1240 by 1240 pixels · infant wide-field retinal image: 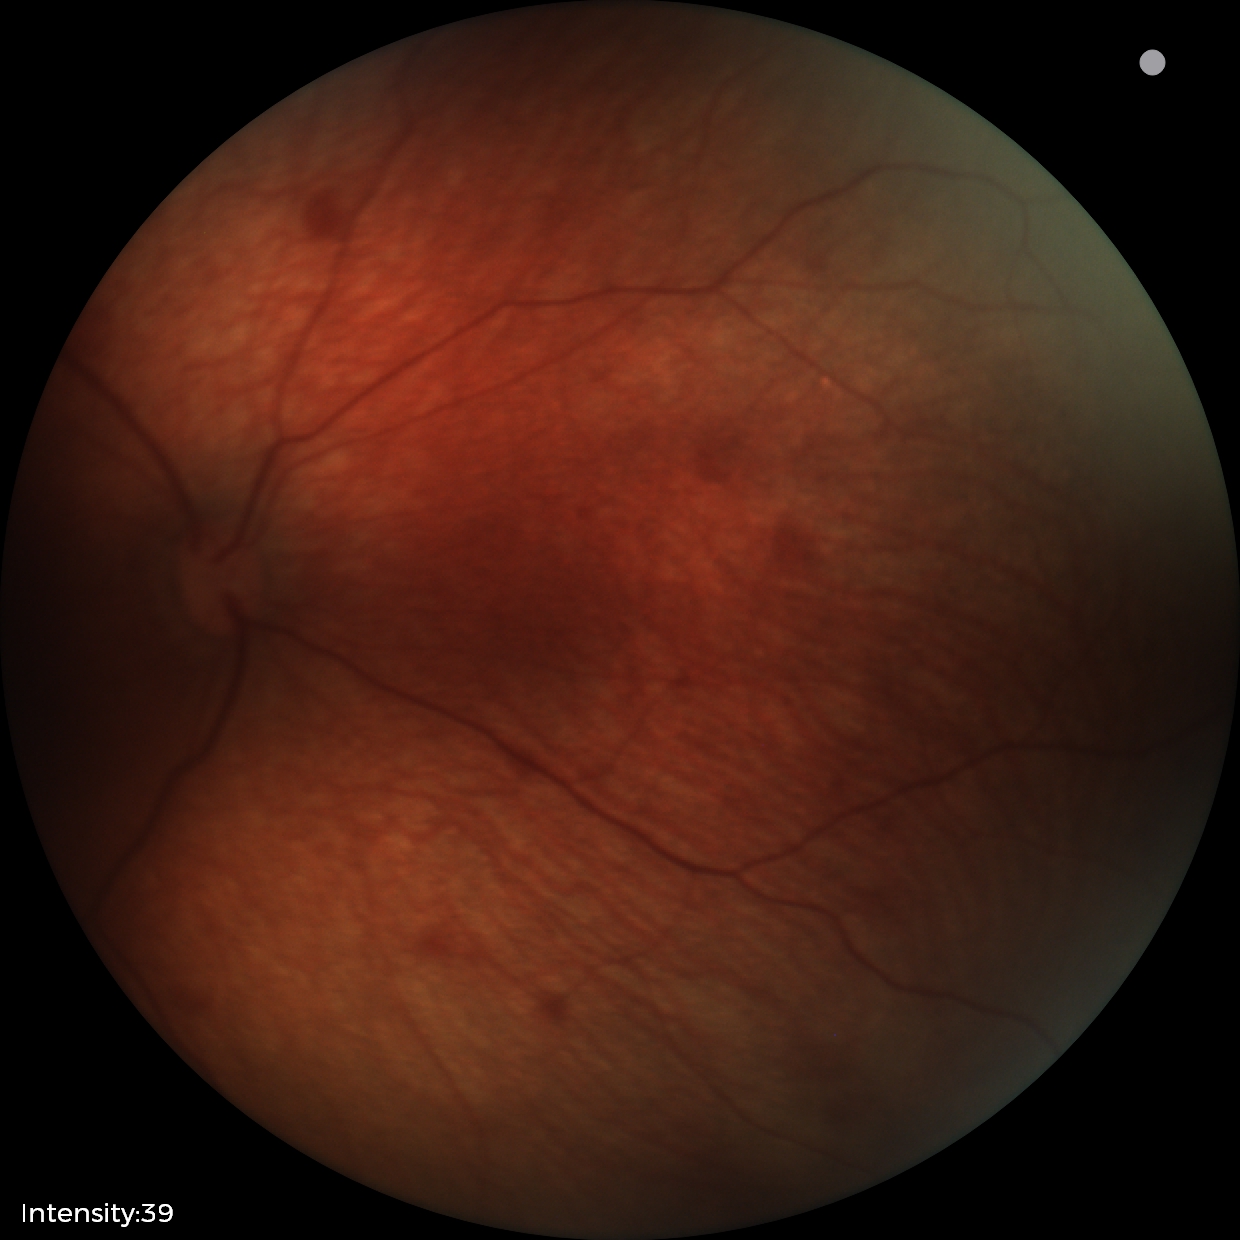 Assessment: retinal hemorrhages.